45° field of view · 1920x1088px · CFP — 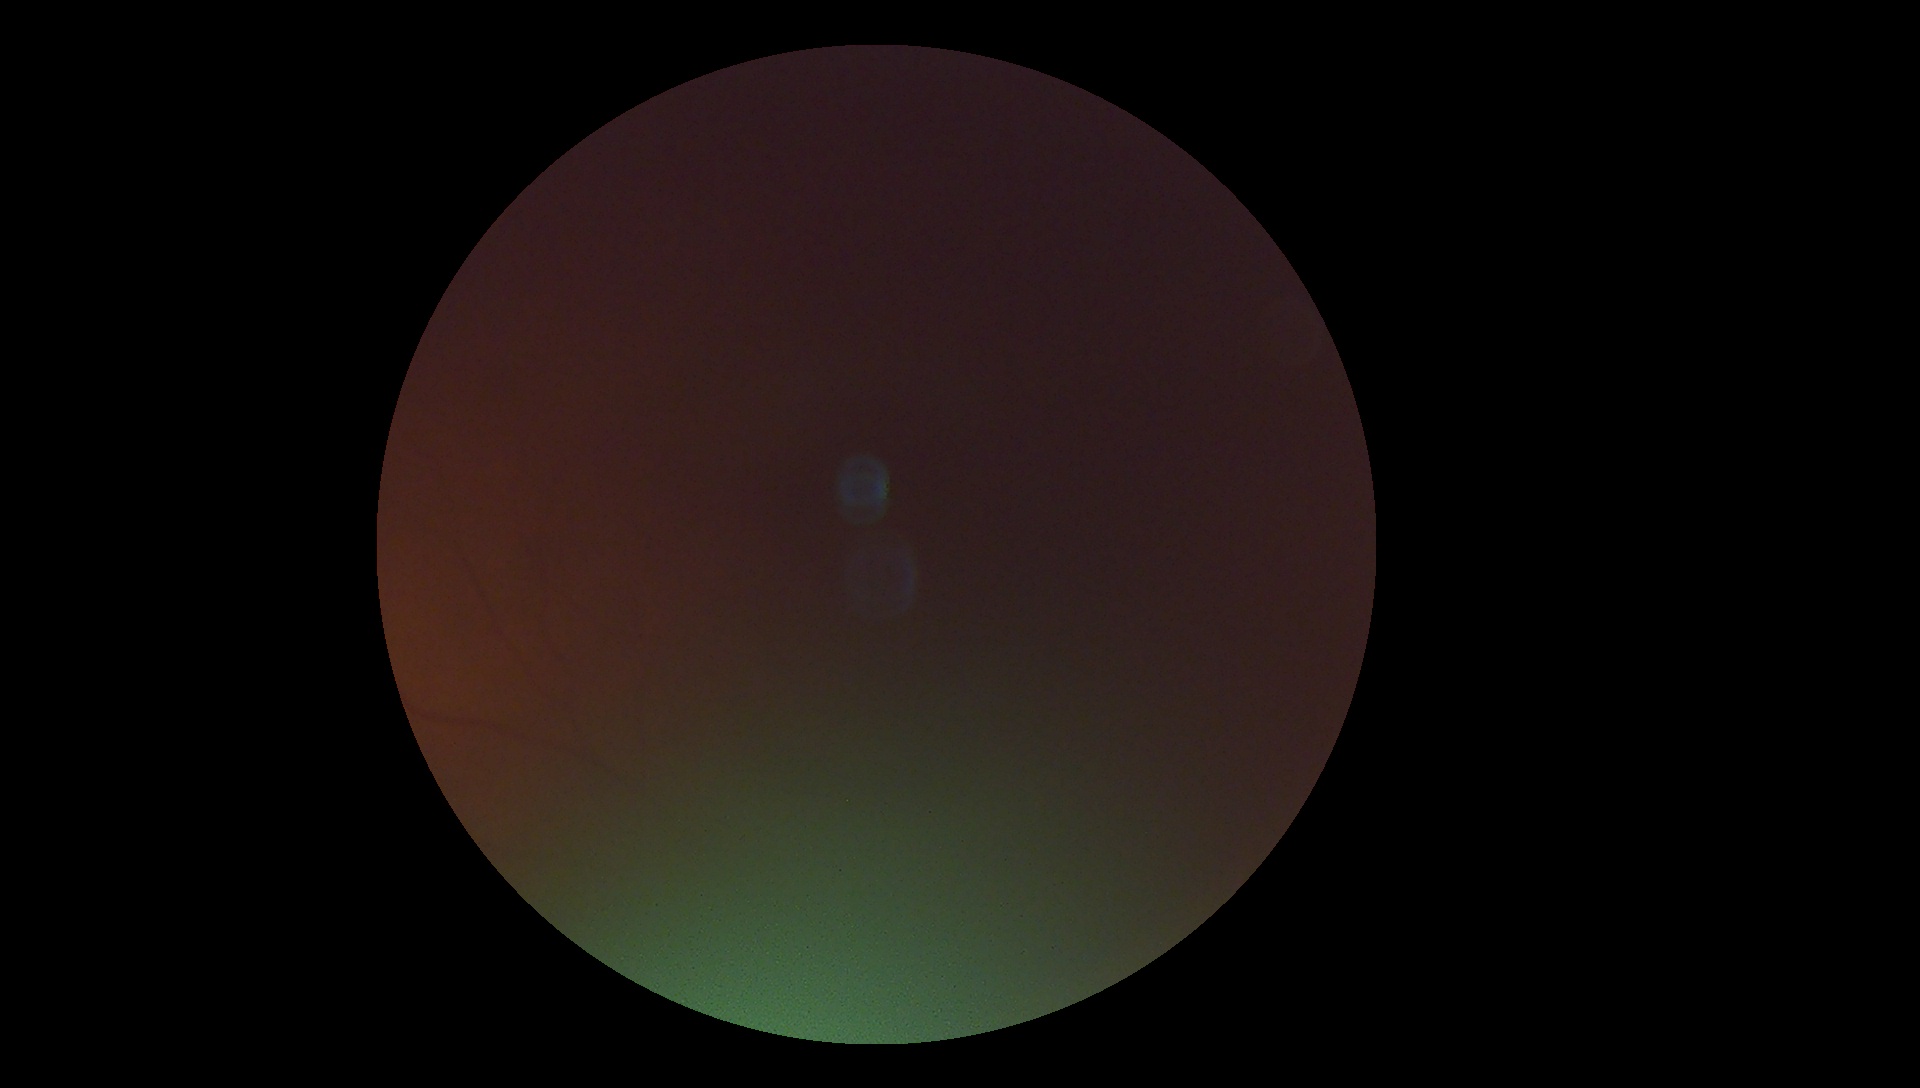

retinopathy: ungradable.